Without pupil dilation · image size 848x848
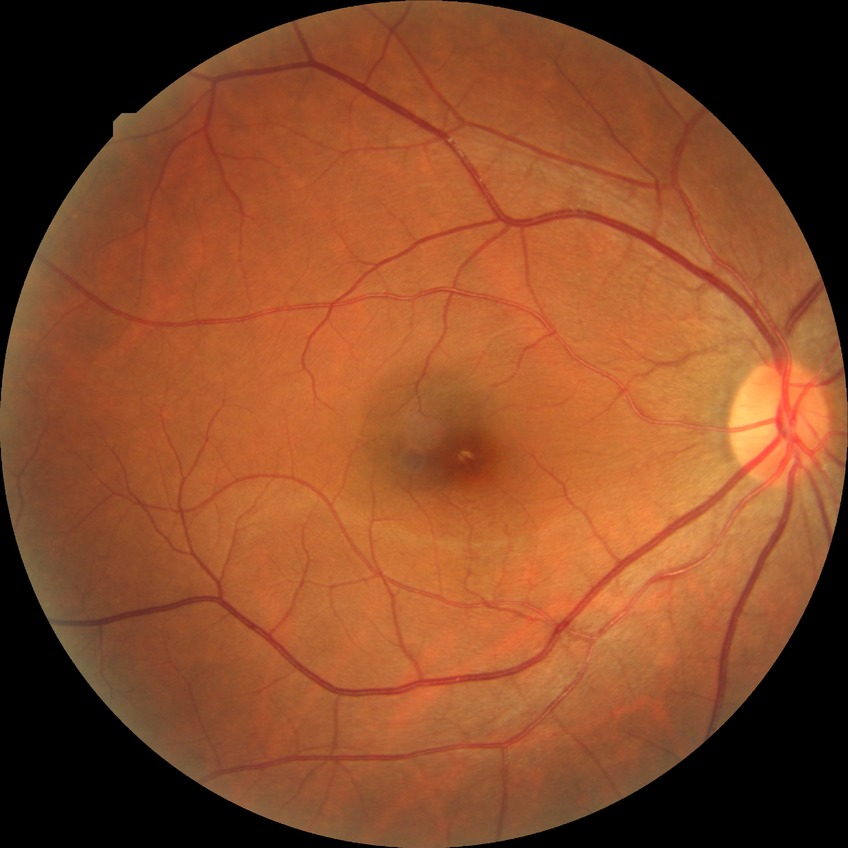   davis_grade: no diabetic retinopathy (NDR)